2352x1568:
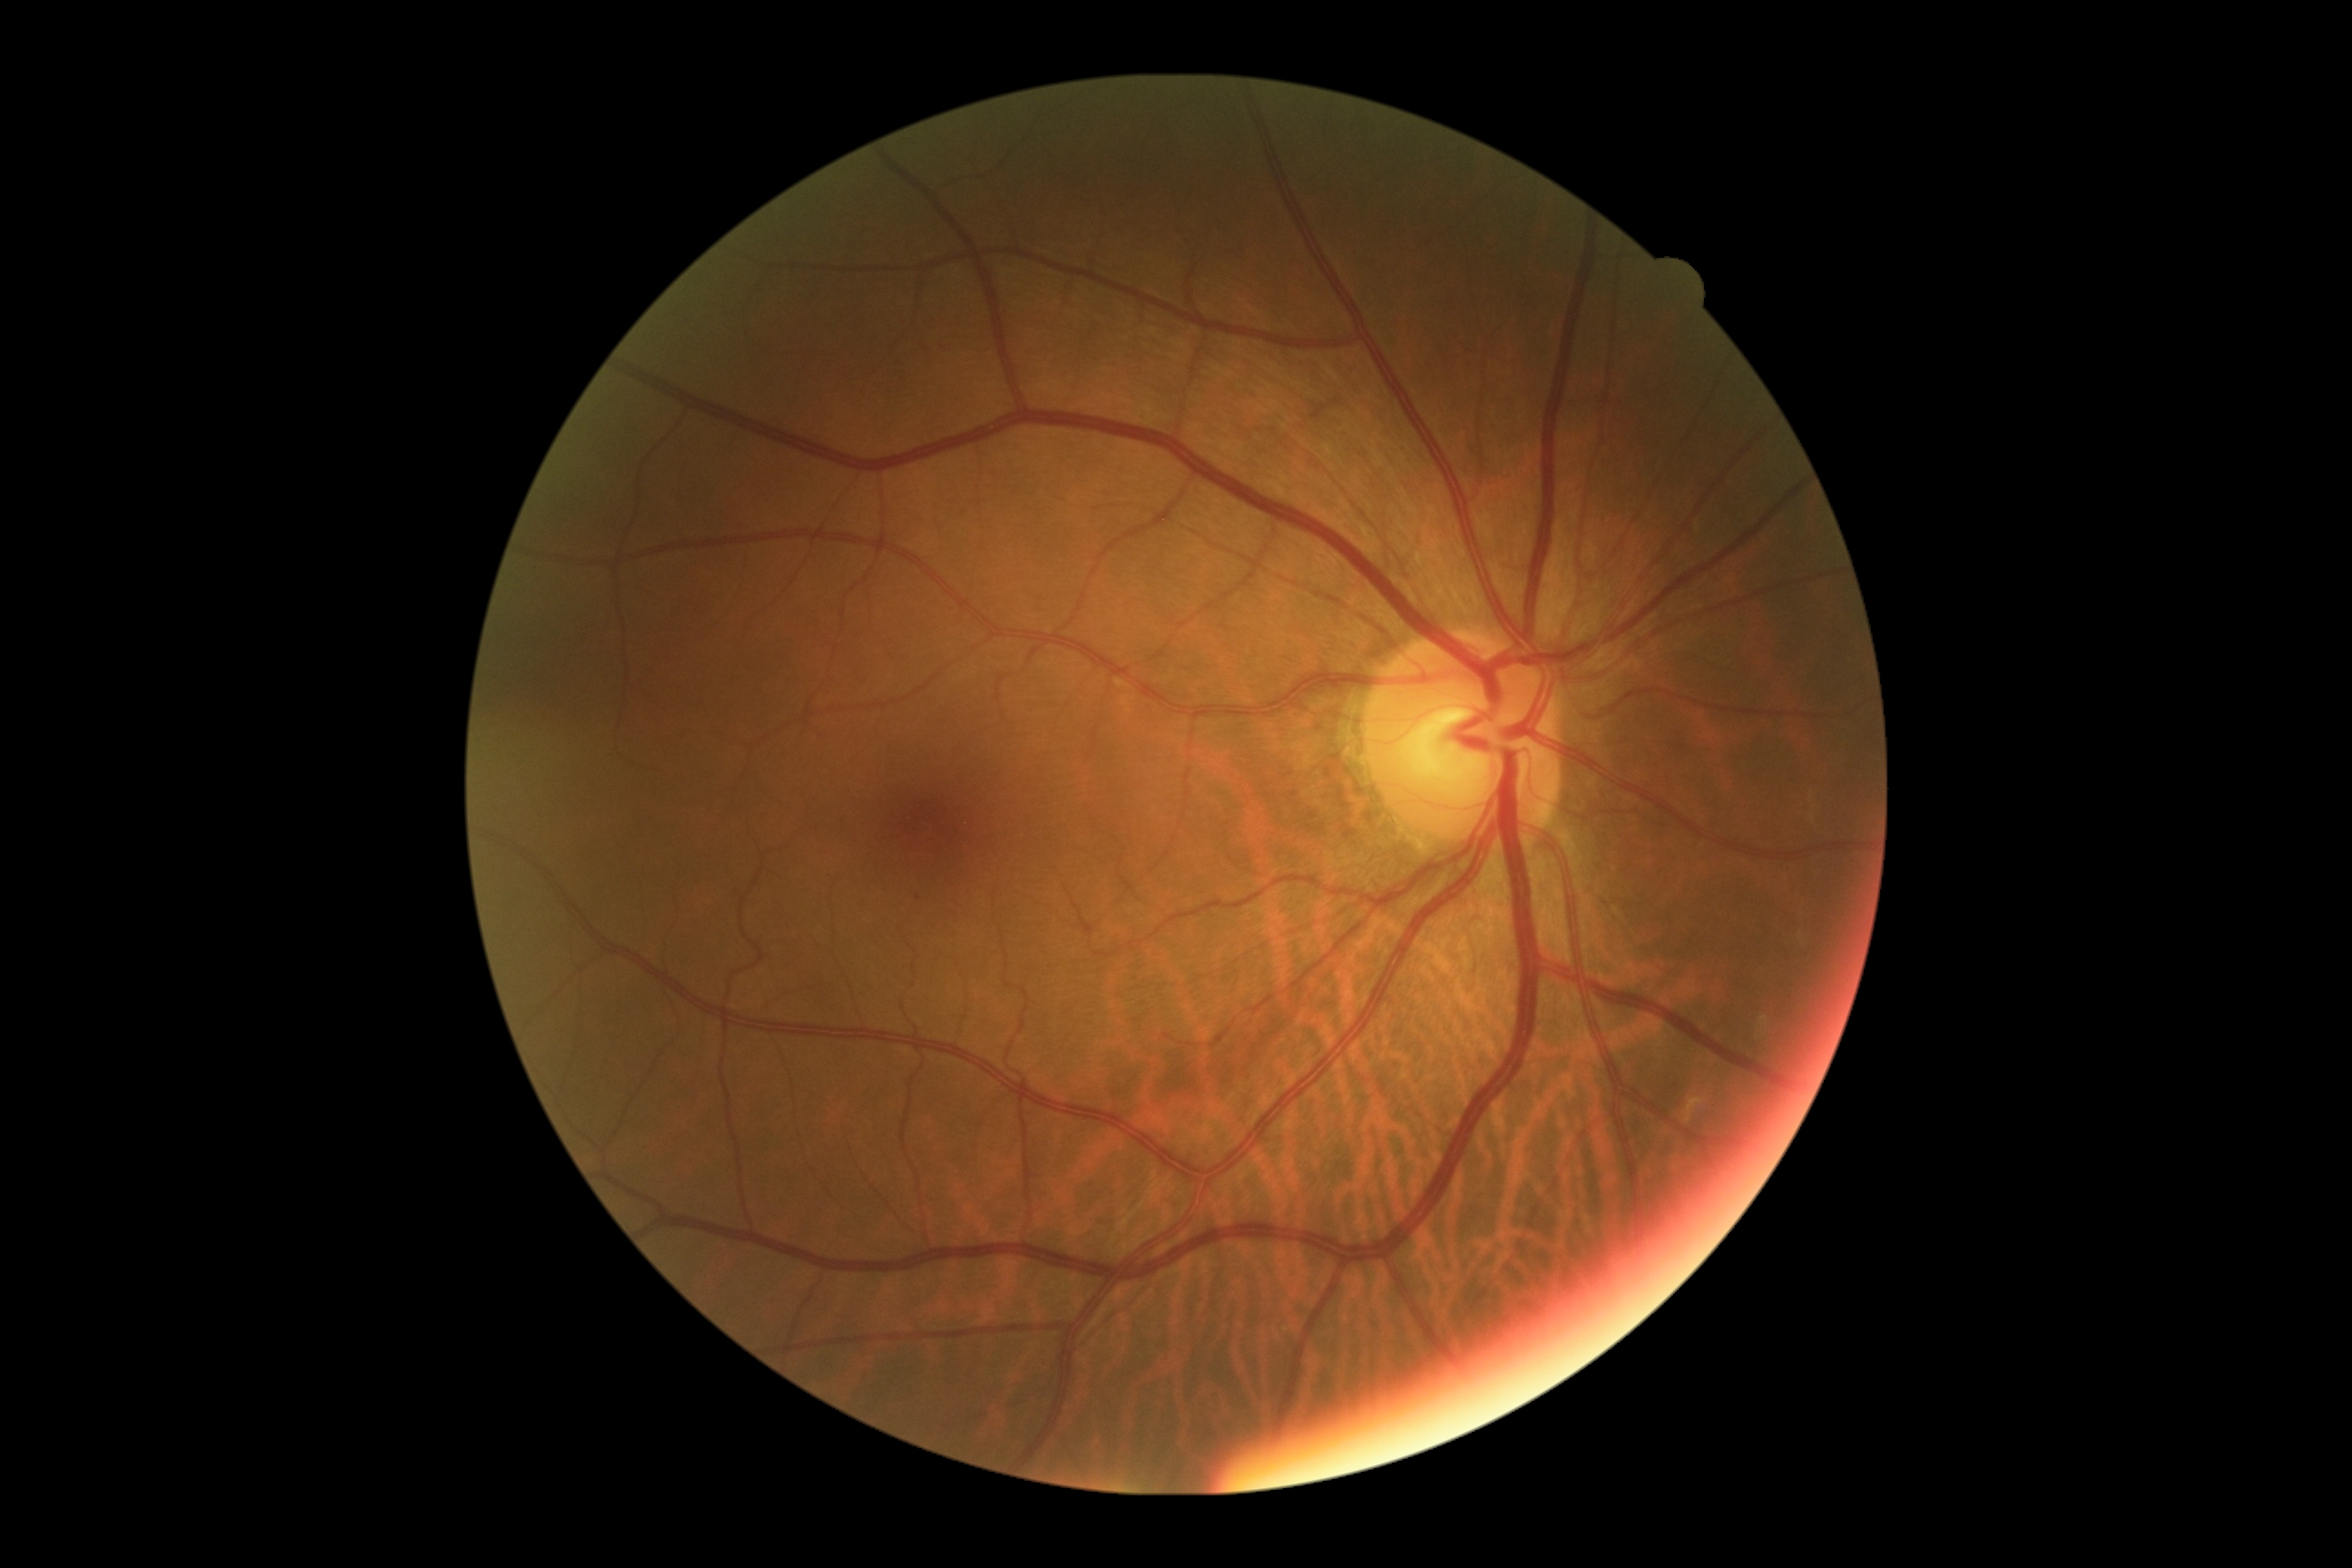

  dr_grade: grade 1 (mild NPDR)